45° field of view · 2352 by 1568 pixels: 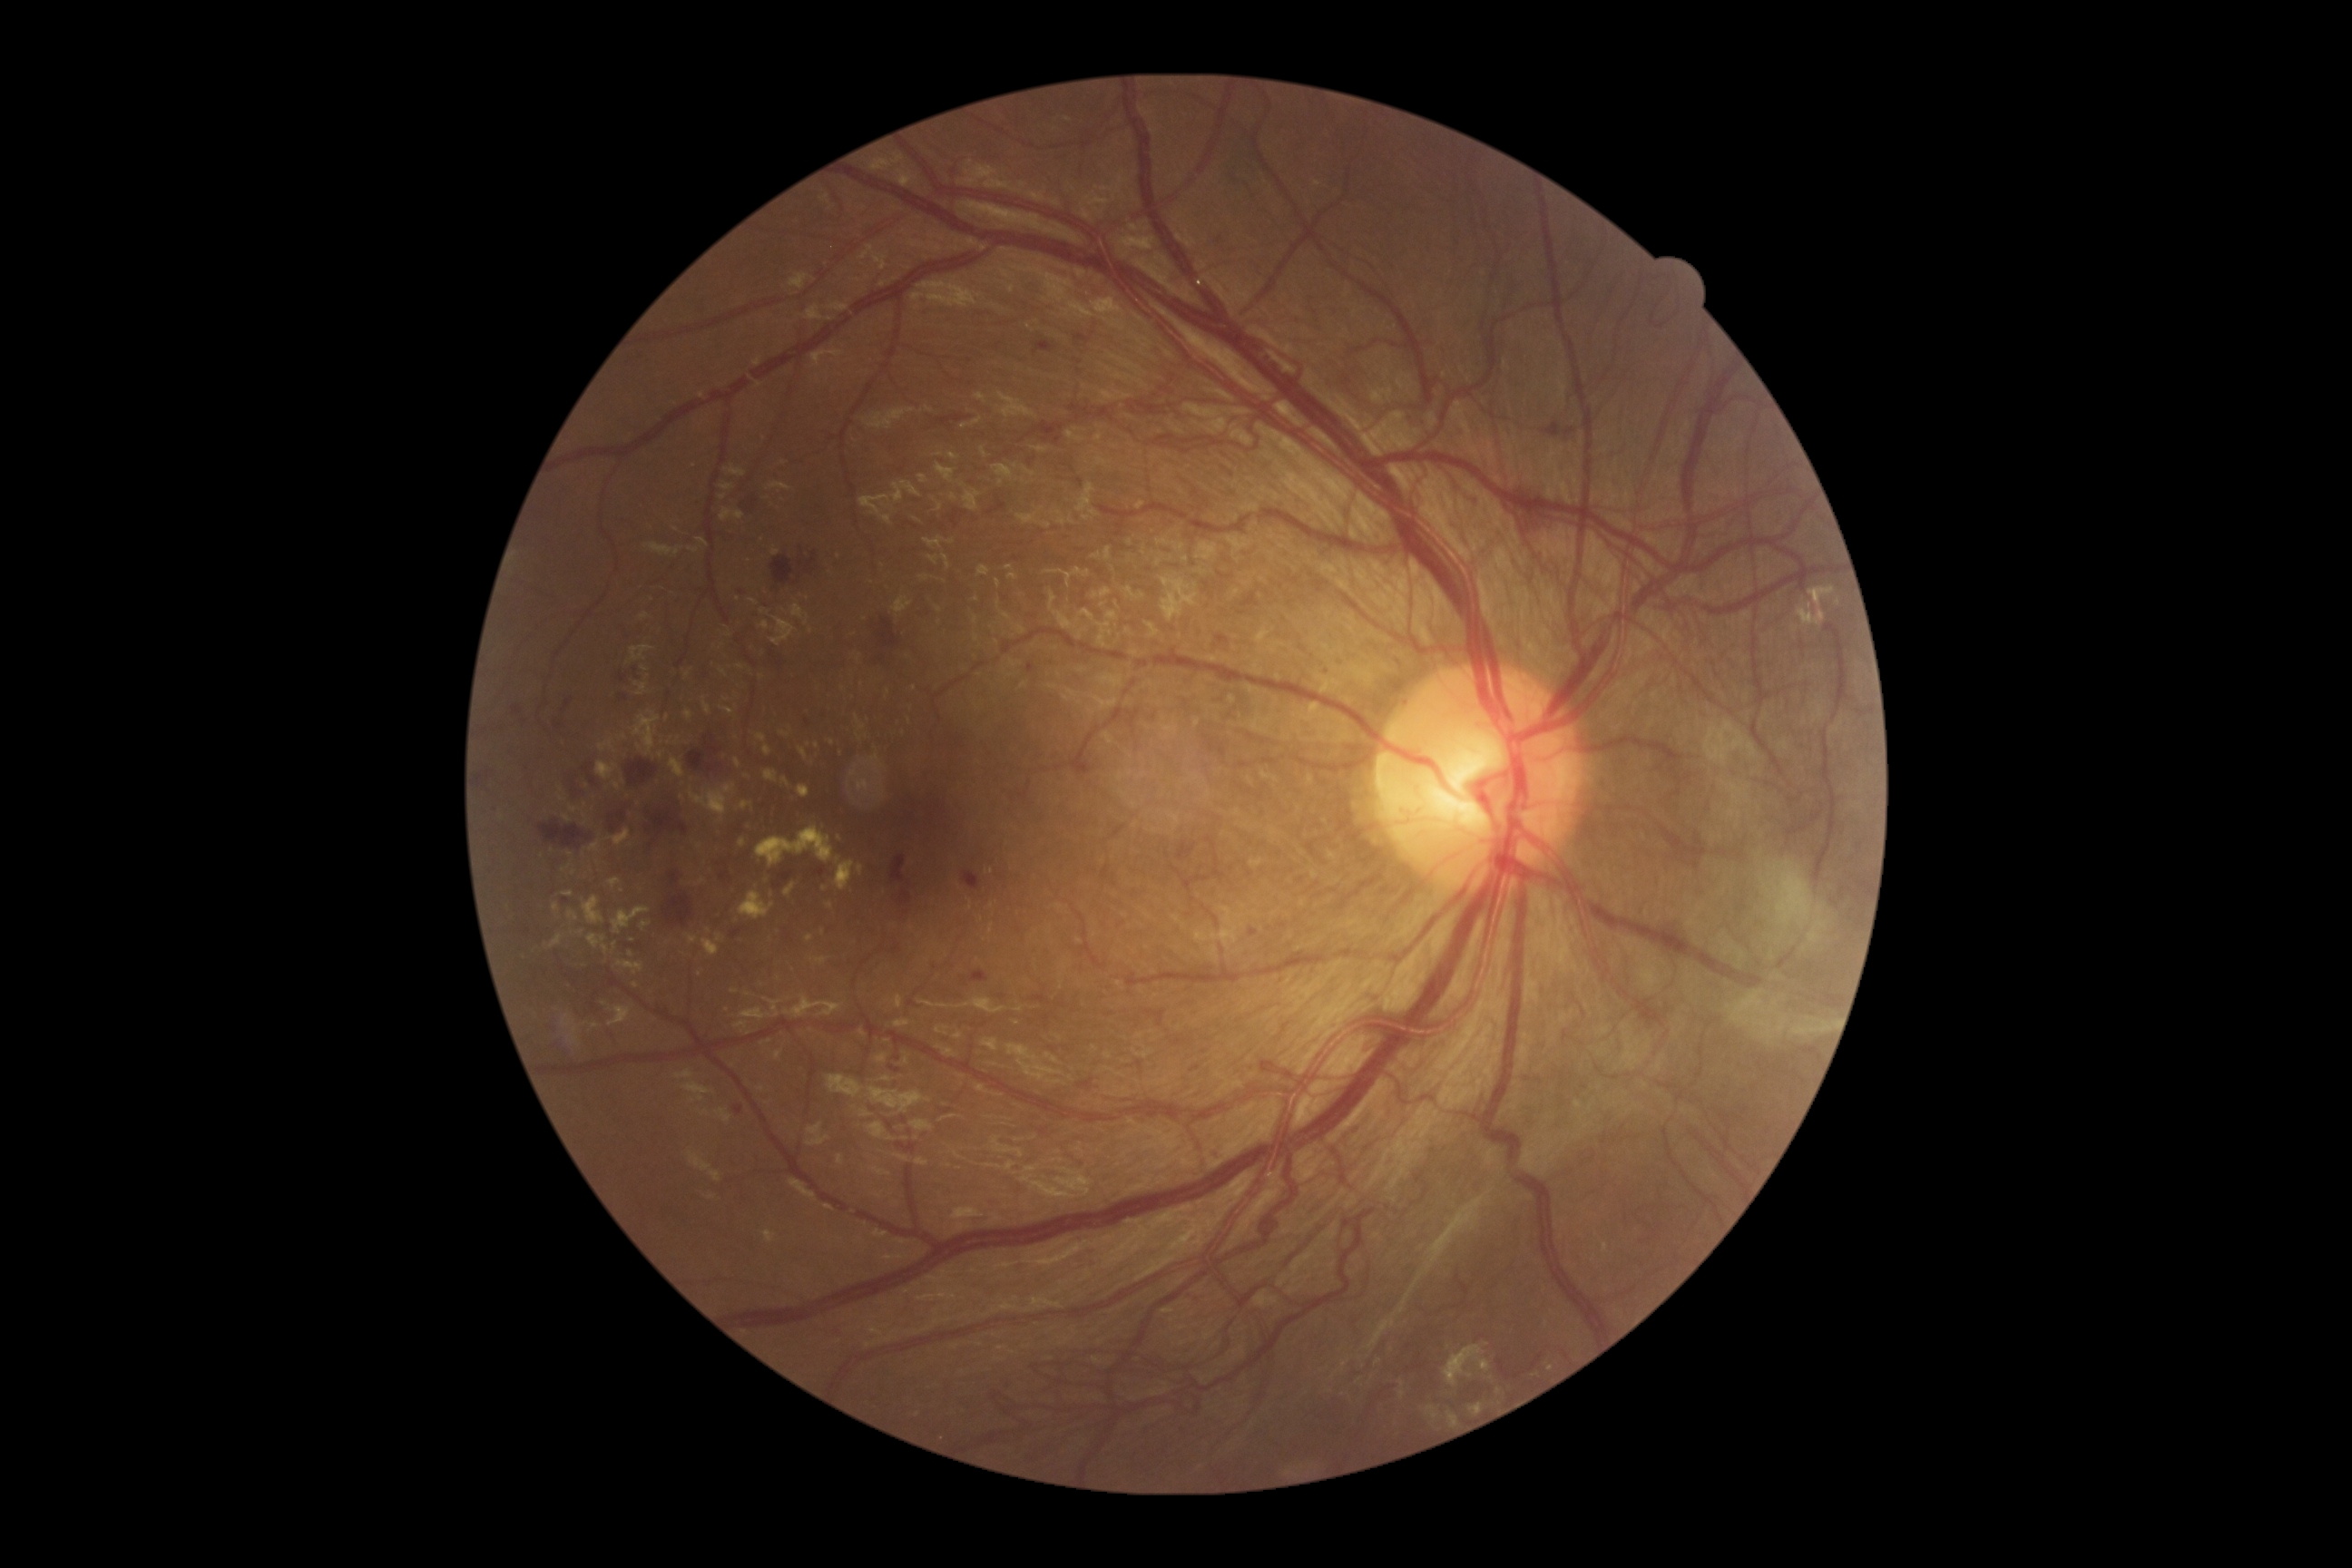

DR stage: proliferative diabetic retinopathy (grade 4)
Lesions identified (partial list):
* MAs: not present
* EXs (partial): [1313, 181, 1322, 188]; [547, 934, 564, 950]; [740, 892, 774, 921]; [756, 827, 834, 868]; [696, 879, 707, 887]; [740, 801, 752, 810]; [763, 1231, 776, 1244]; [799, 747, 808, 761]; [720, 669, 729, 678]; [631, 645, 654, 662]
* Small EXs approximately at [910, 721]; [839, 838]; [621, 892]; [561, 798]; [808, 745]; [567, 869]; [661, 755]; [741, 667]; [747, 994]
* HEs (partial): [890, 943, 903, 956]; [1455, 426, 1465, 438]; [936, 415, 972, 427]; [1028, 422, 1066, 446]; [687, 750, 718, 772]; [963, 872, 981, 890]; [1398, 700, 1409, 709]; [765, 645, 787, 671]; [807, 553, 818, 574]; [538, 821, 589, 848]; [1320, 665, 1331, 680]; [705, 734, 714, 741]; [513, 705, 522, 716]; [705, 743, 721, 756]
* Small HEs approximately at [624, 697]; [907, 913]; [742, 592]
* SEs: not present